45° FOV · fundus photo: 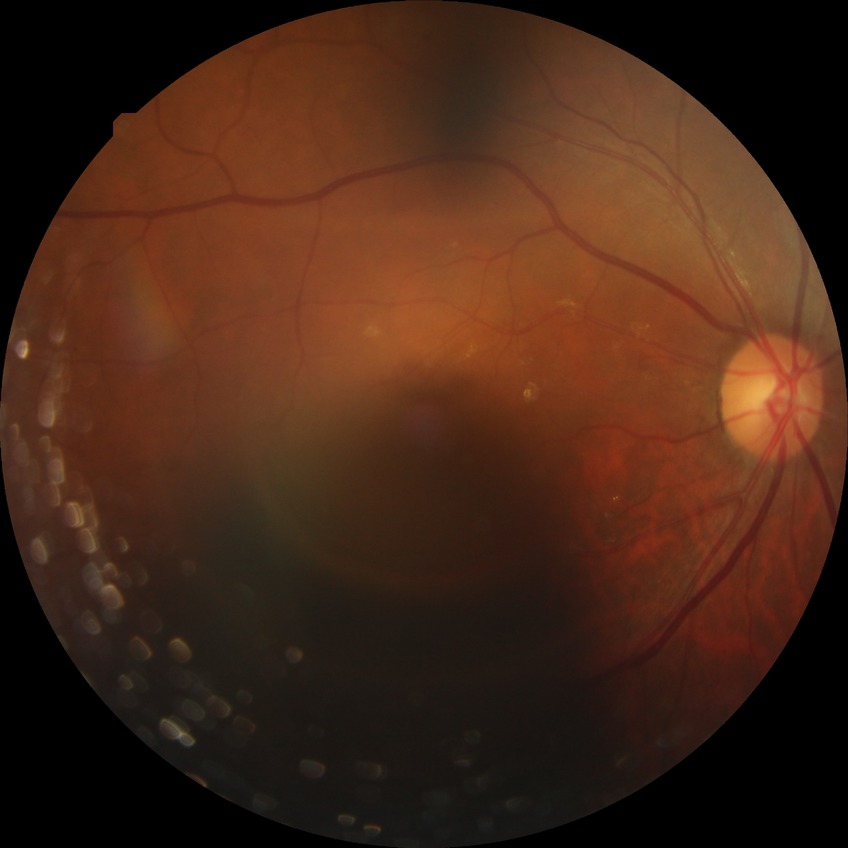

• DR severity: SDR